45° FOV.
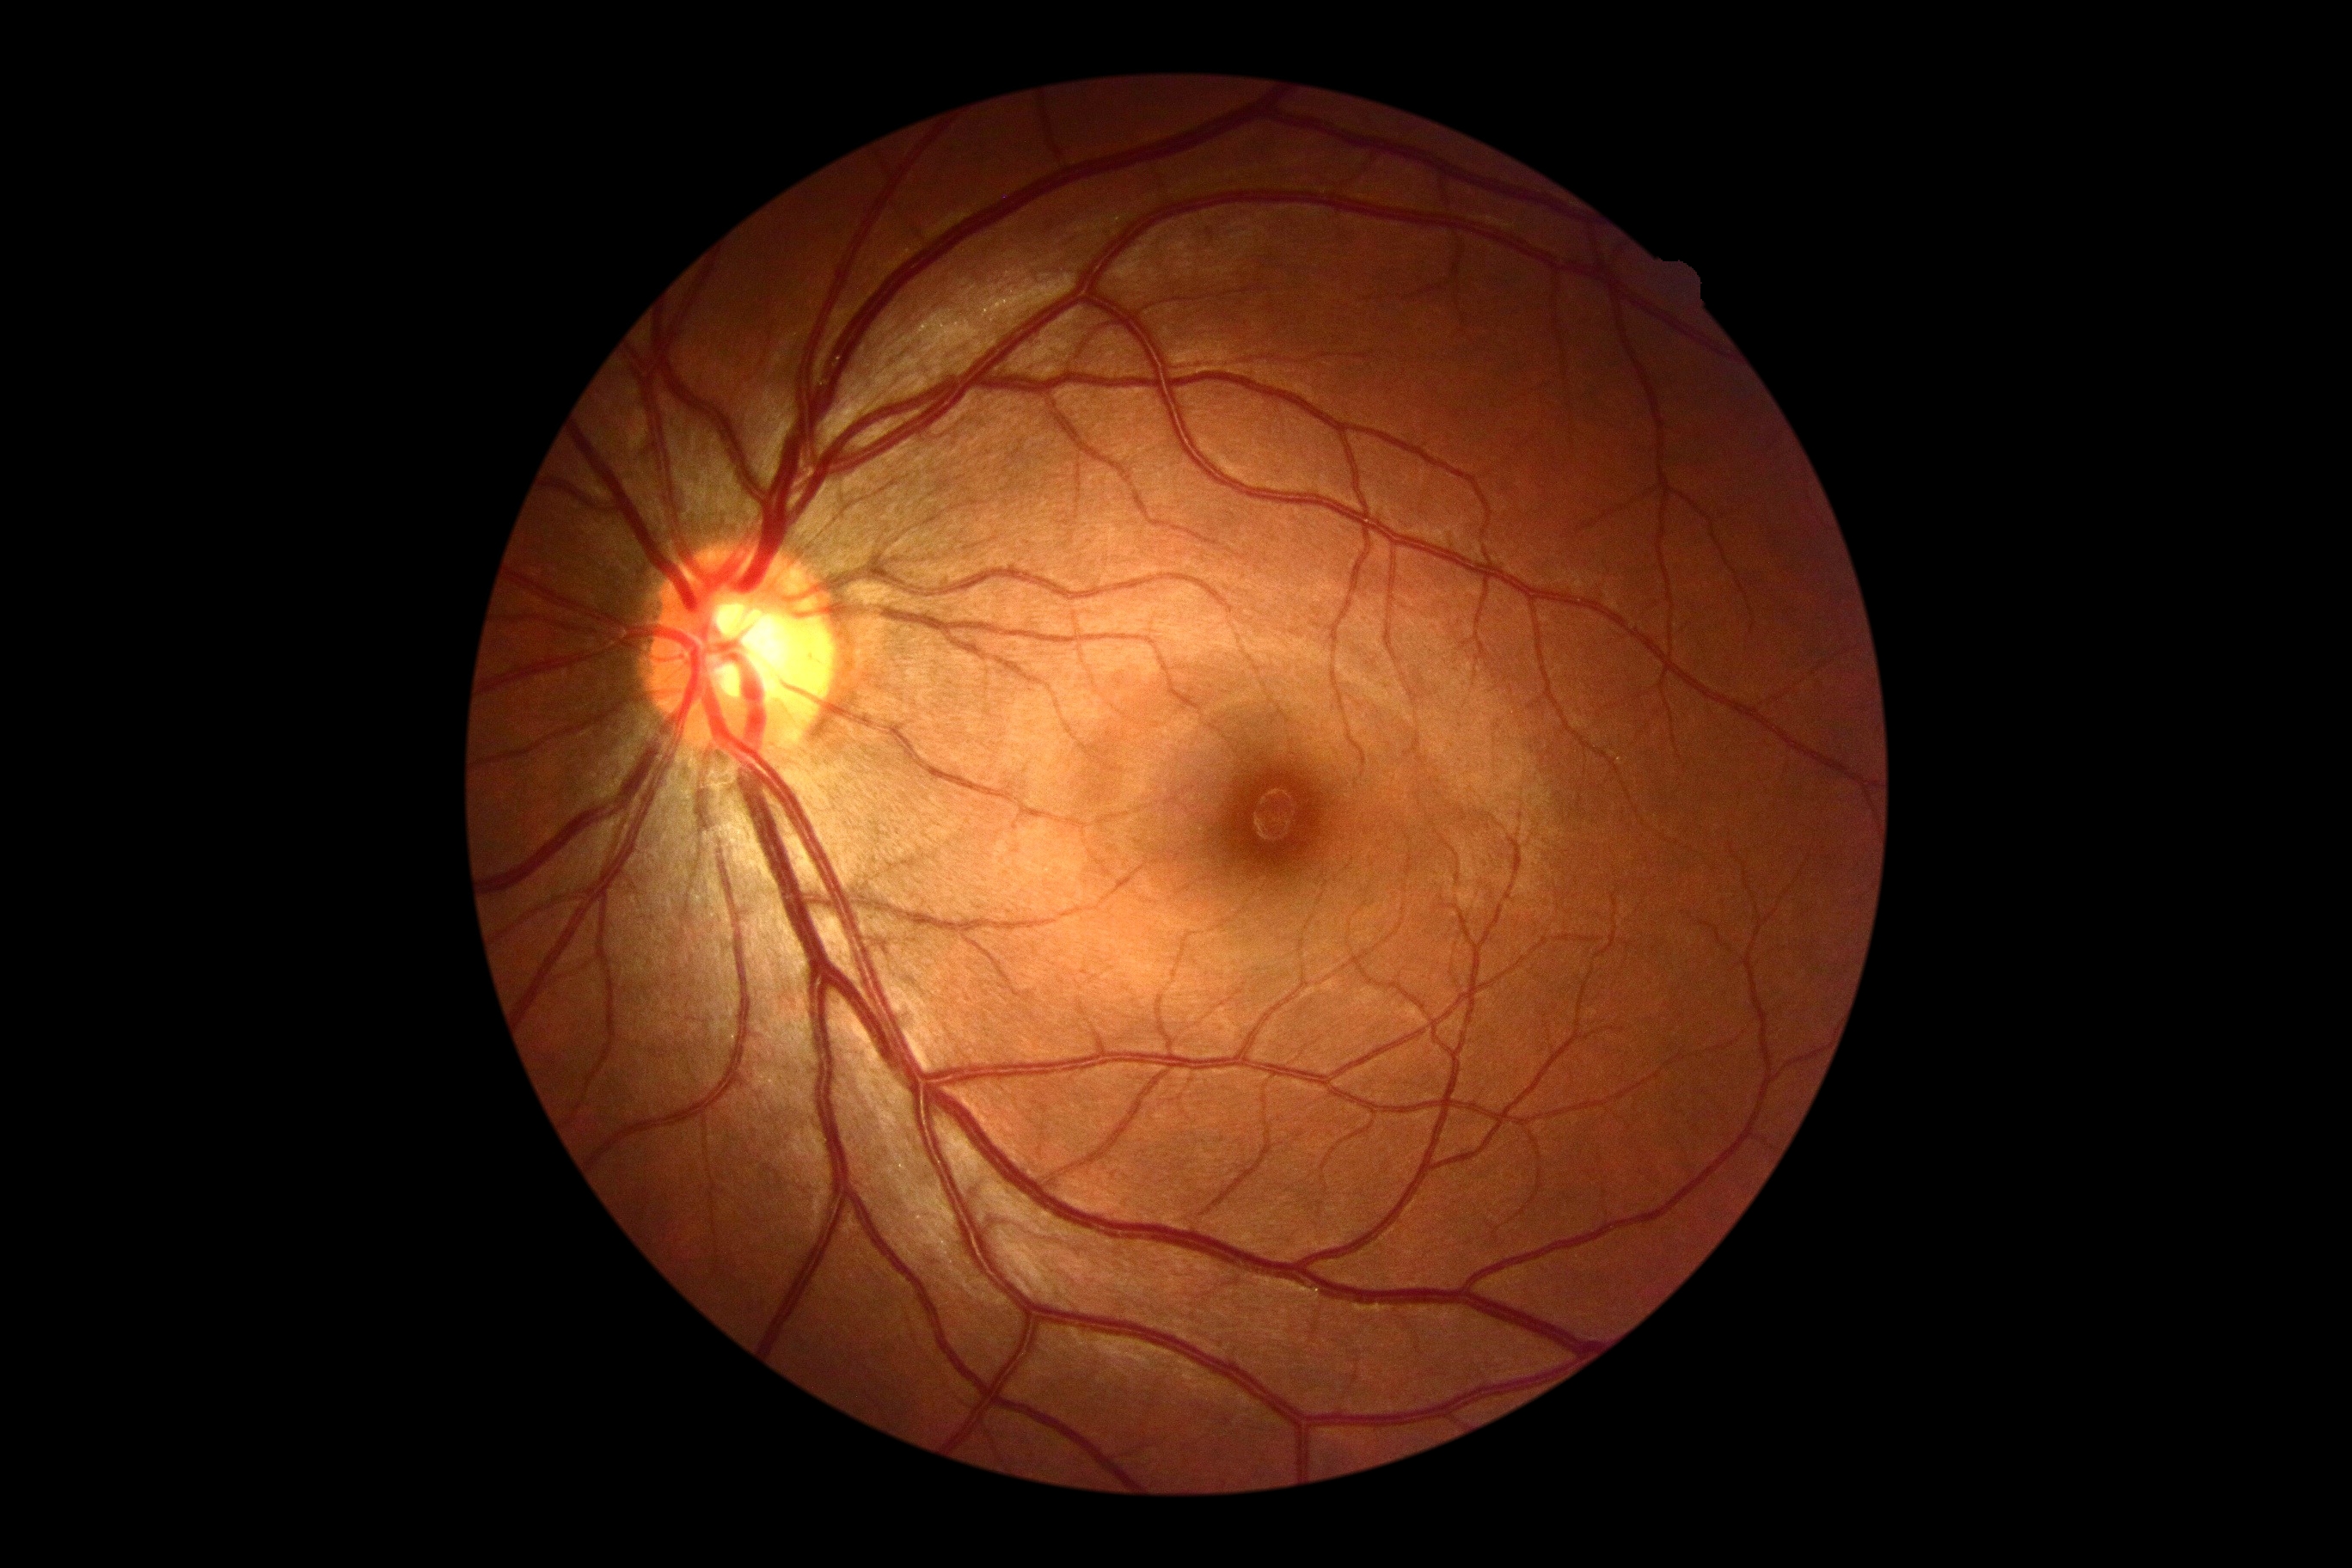 Retinopathy grade: 0.